UWF retinal mosaic
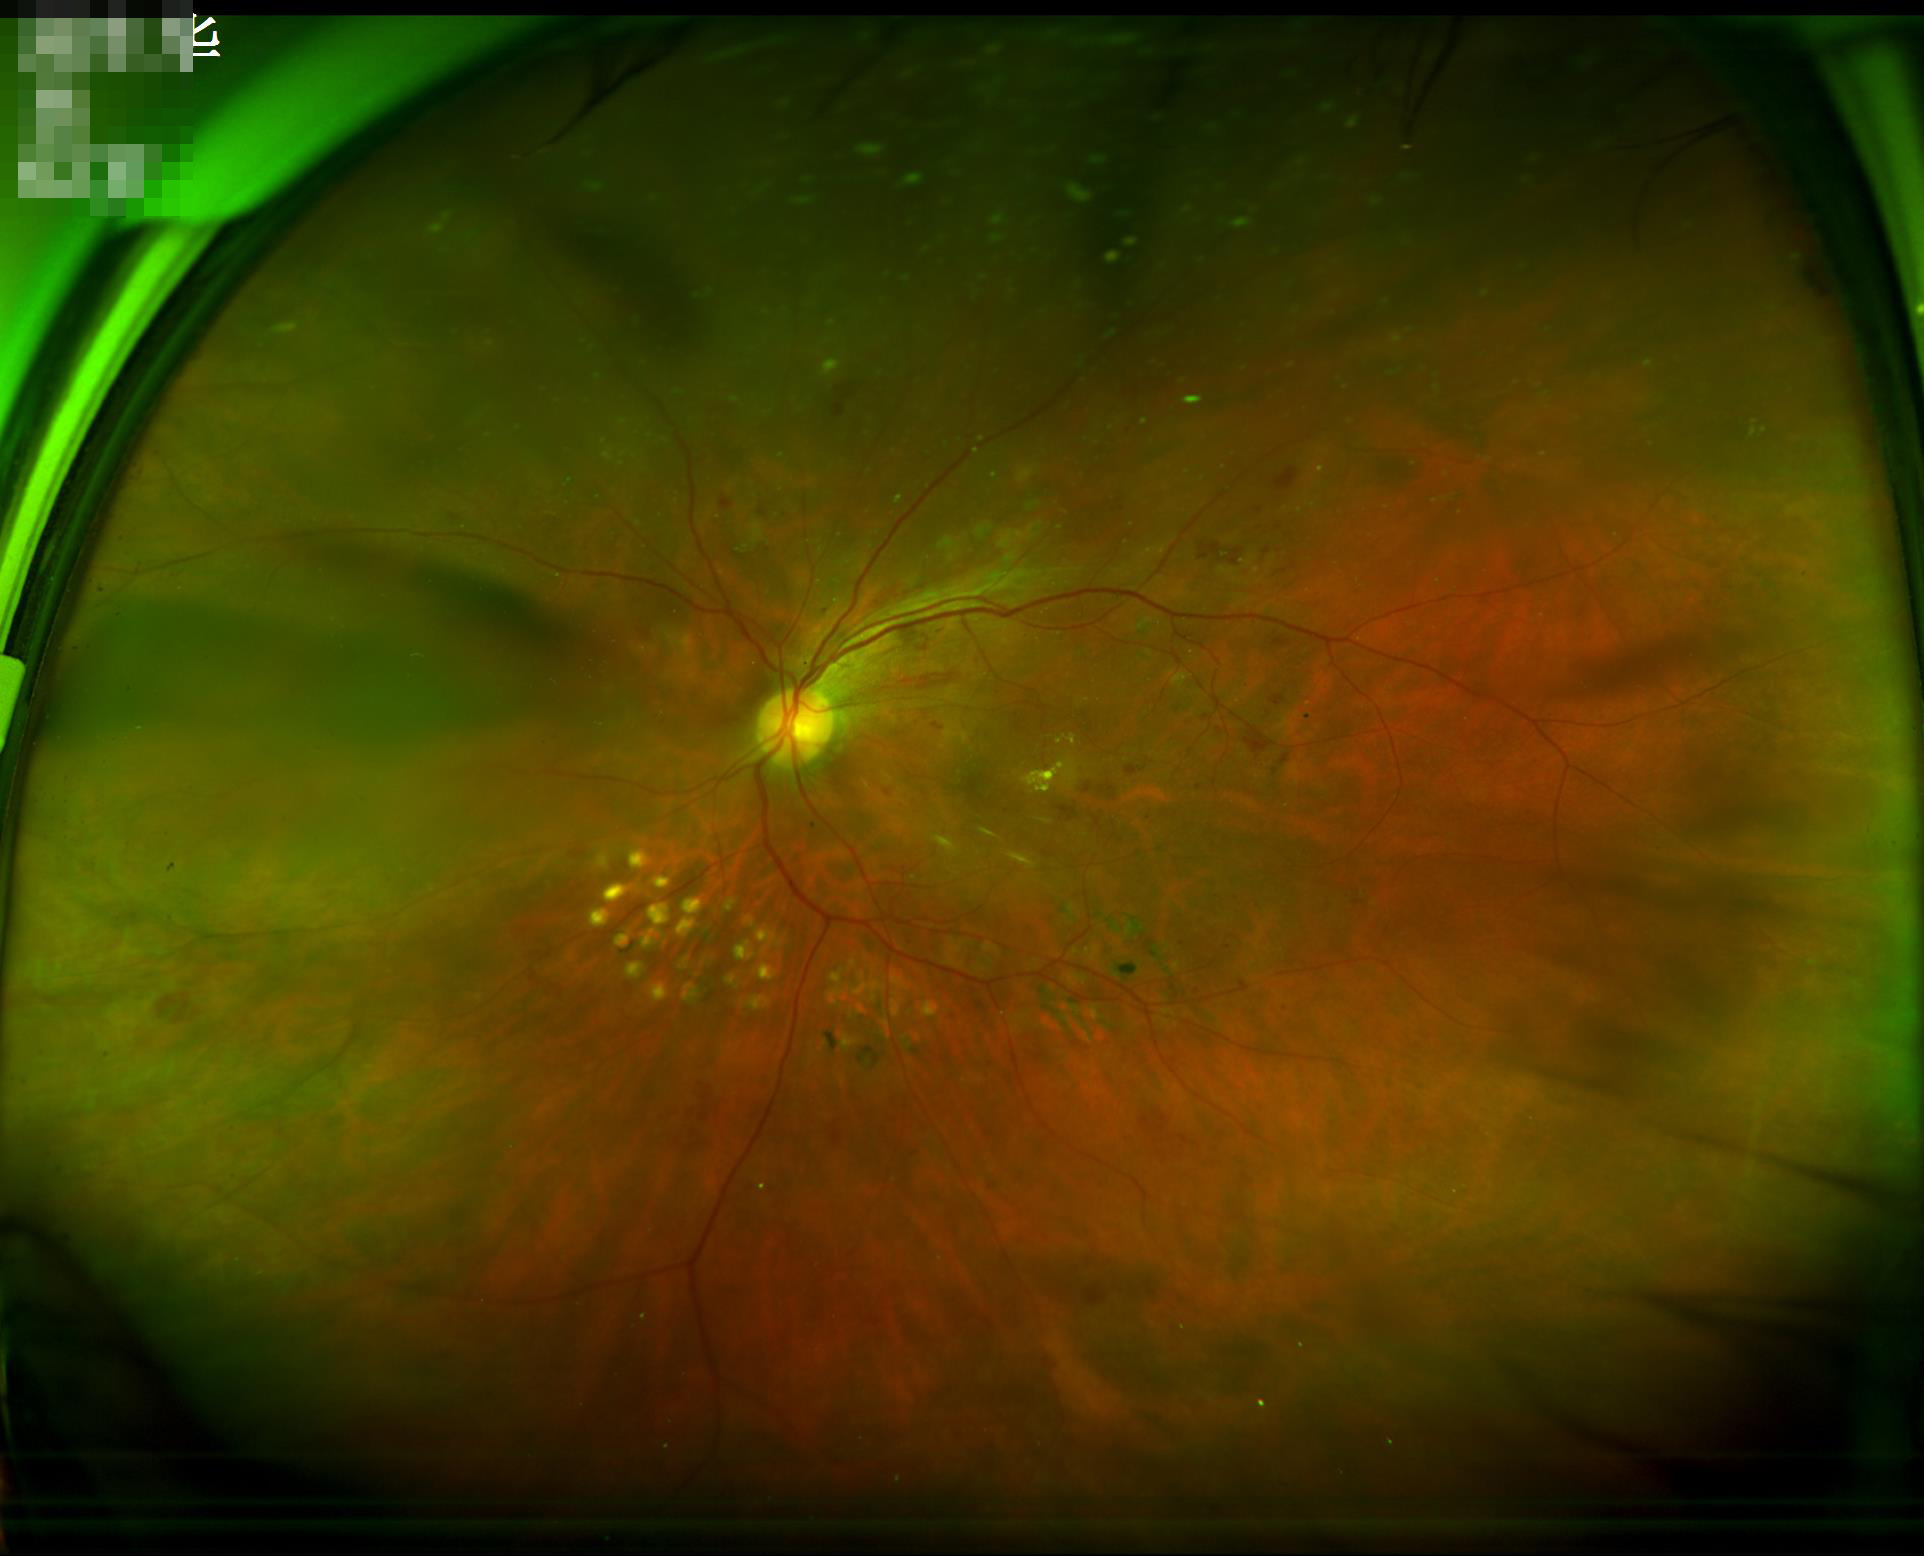
Contrast is good.
Reduced sharpness with visible blur.
Image quality is suboptimal.